1920x1440px · color fundus image: 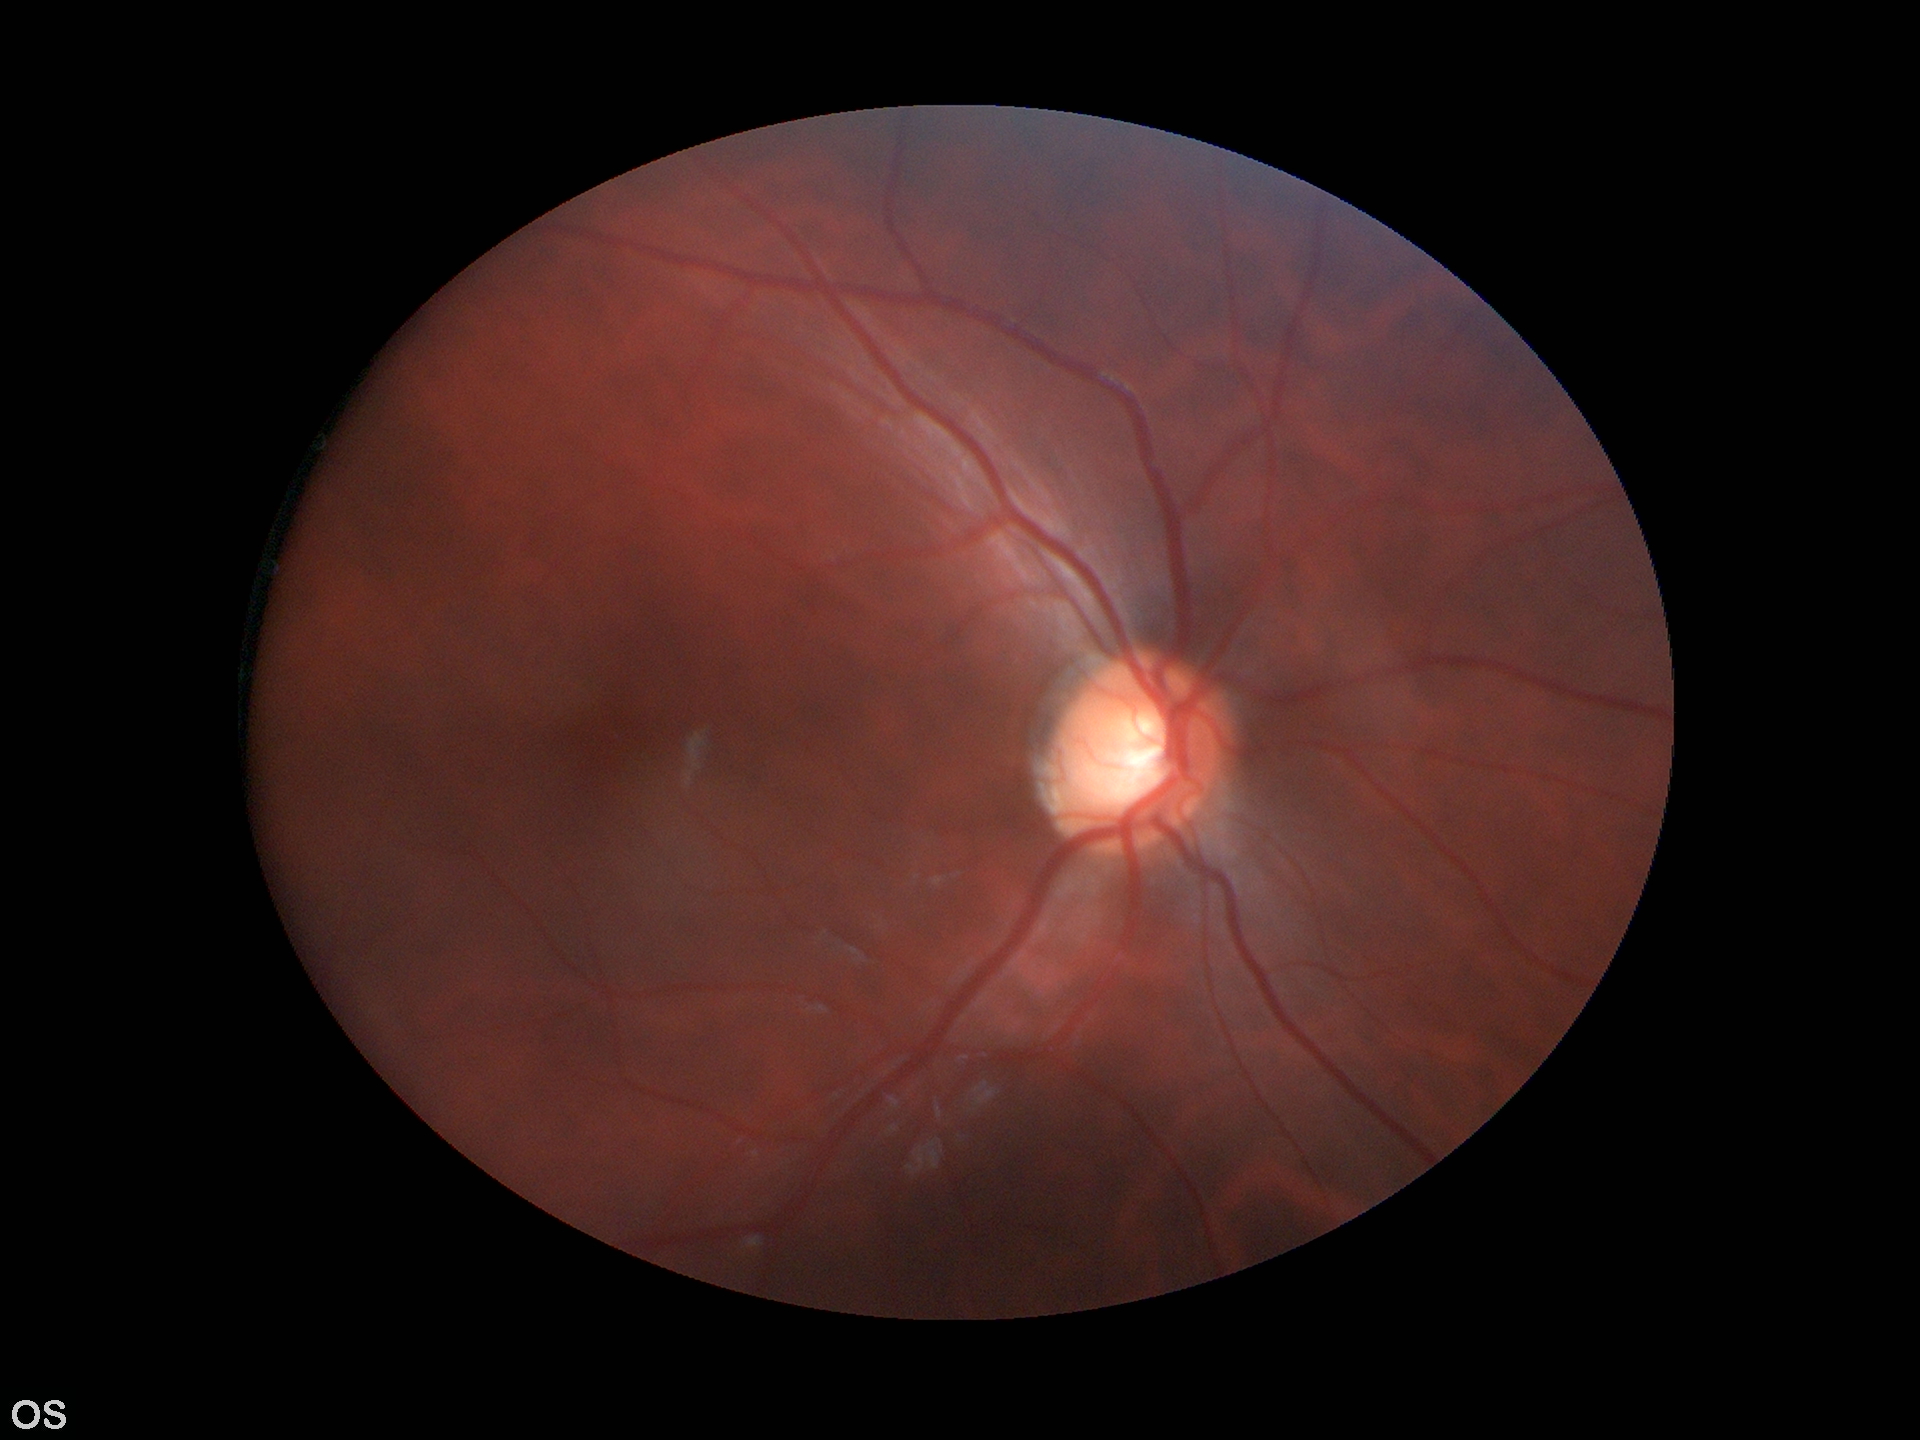 {
  "glaucoma_decision": "suspect",
  "vcdr": "0.63"
}